Retinal fundus photograph: 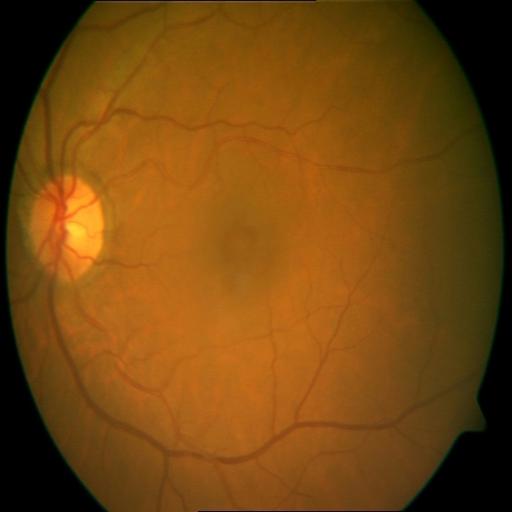
Findings:
- cystoid macular edema